2212 by 1659 pixels — 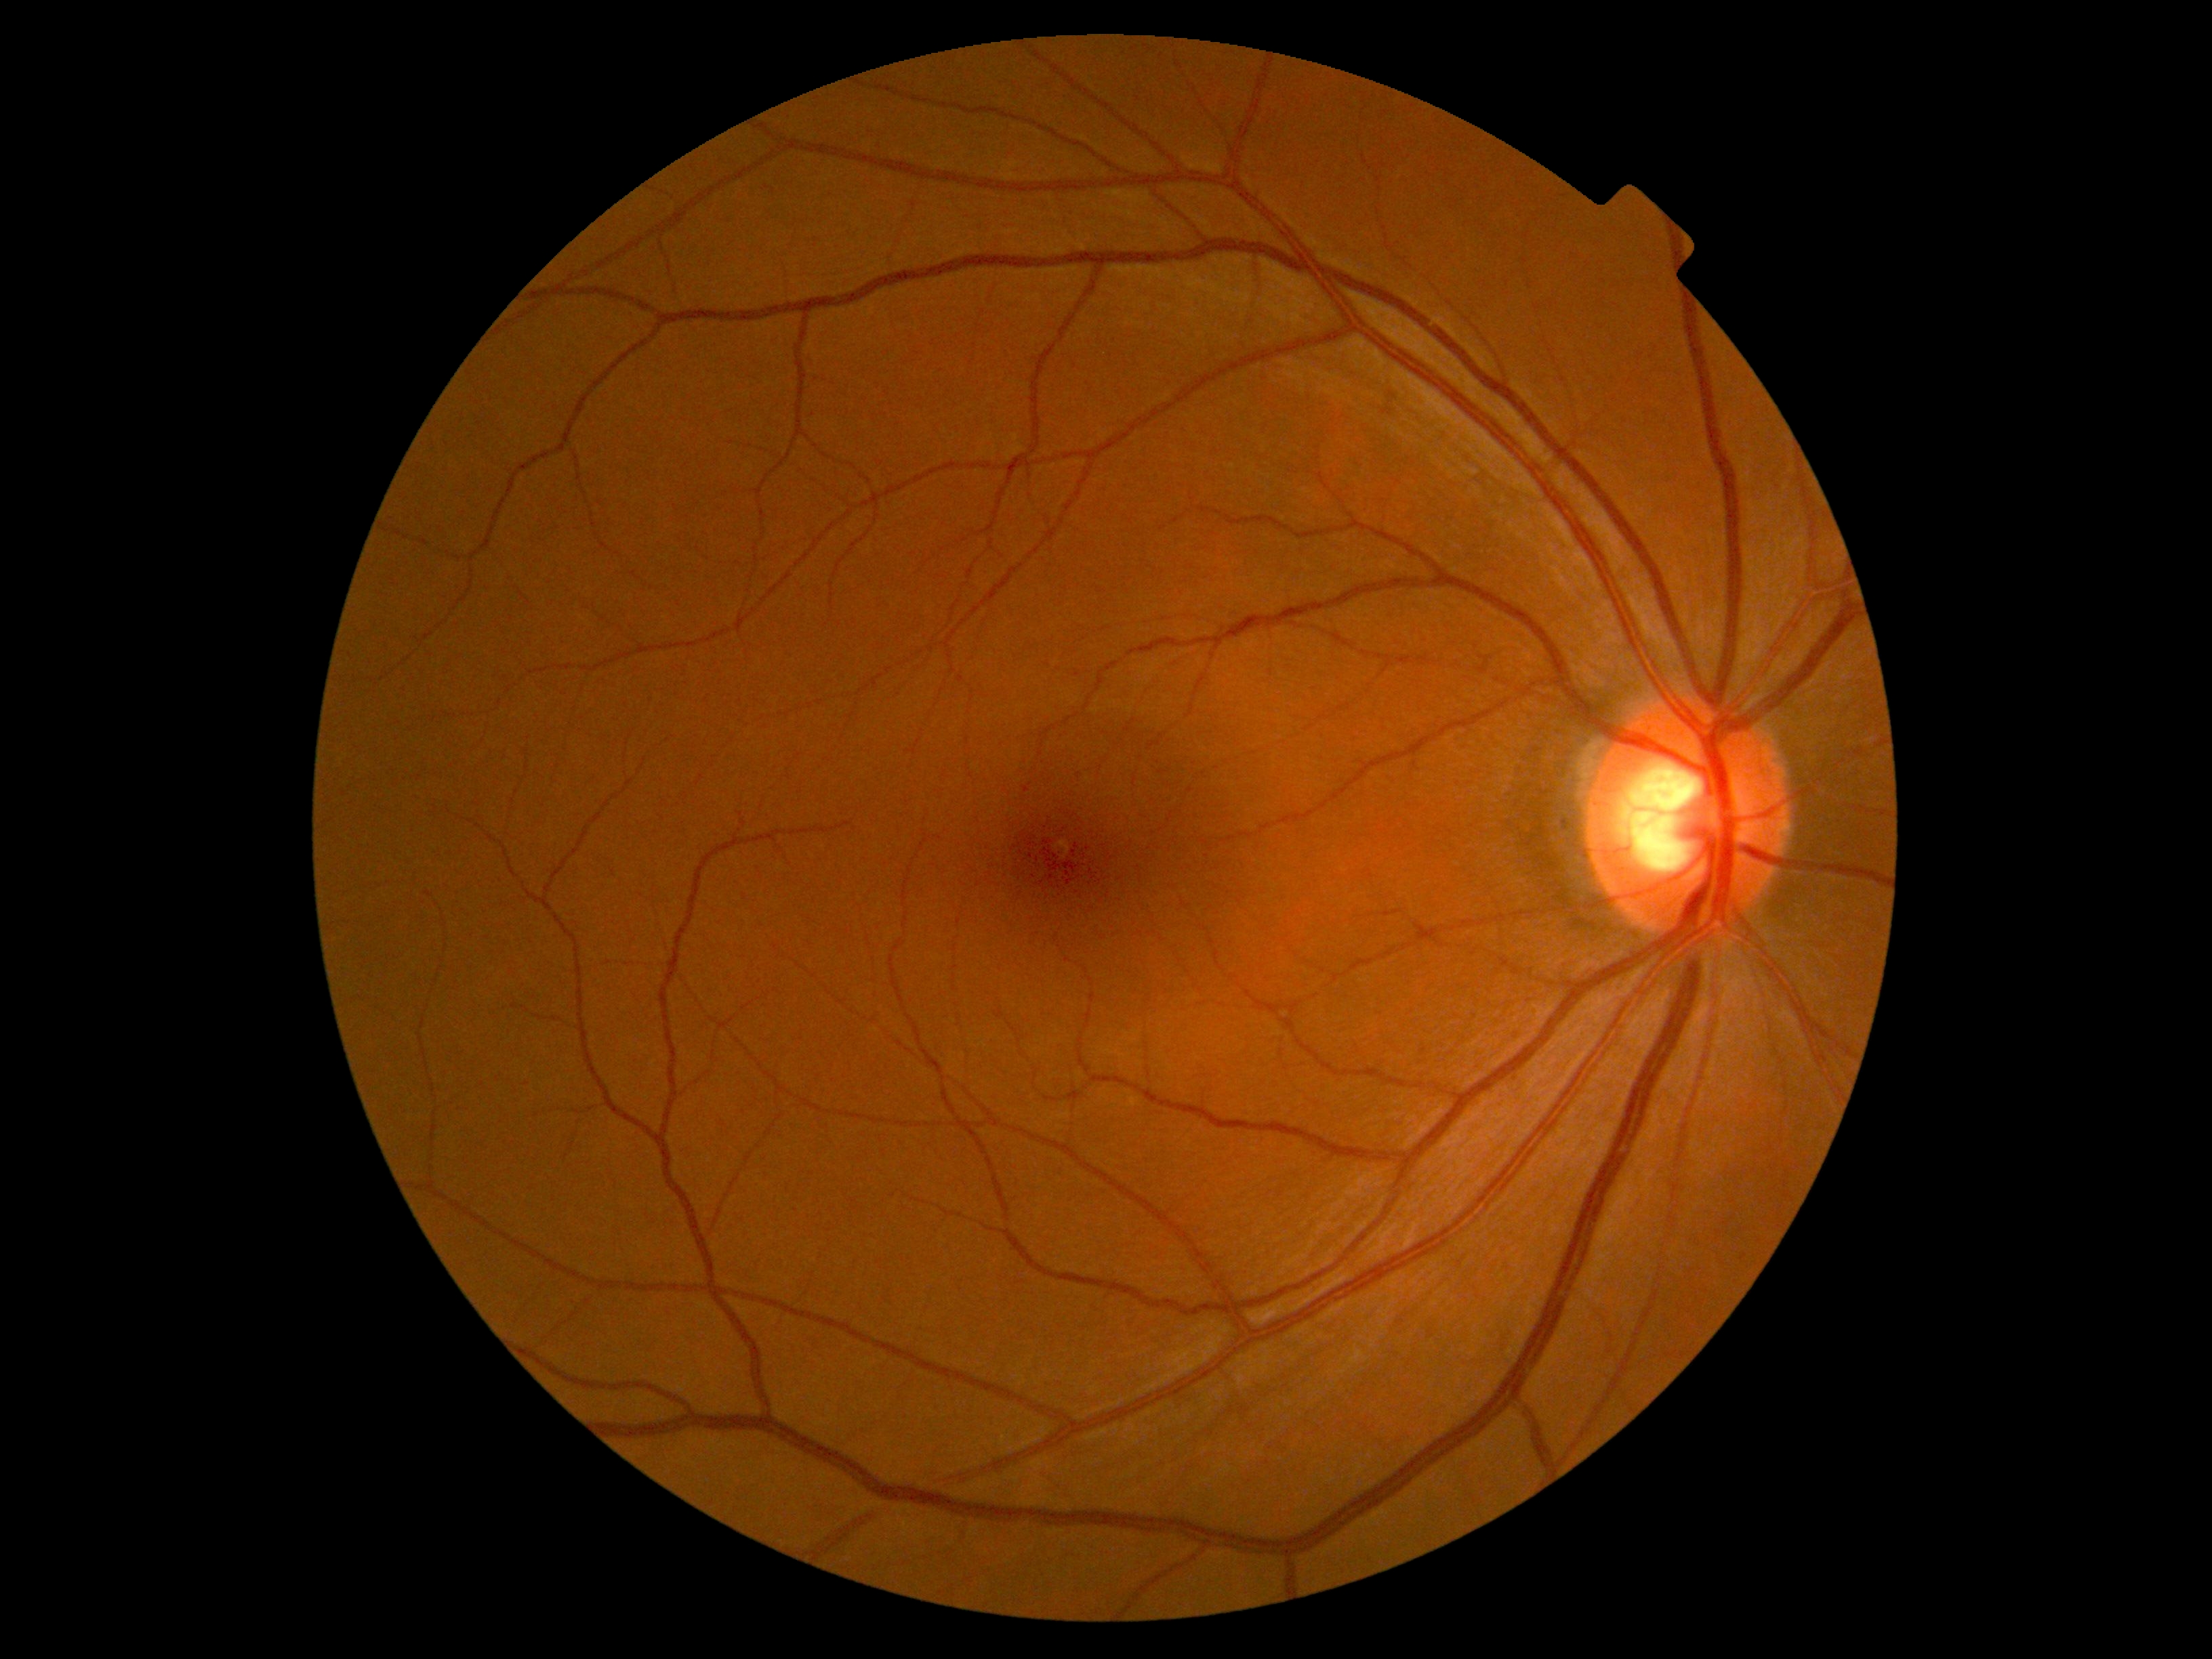
DR severity = no apparent diabetic retinopathy (grade 0); DR impression = no signs of DR.